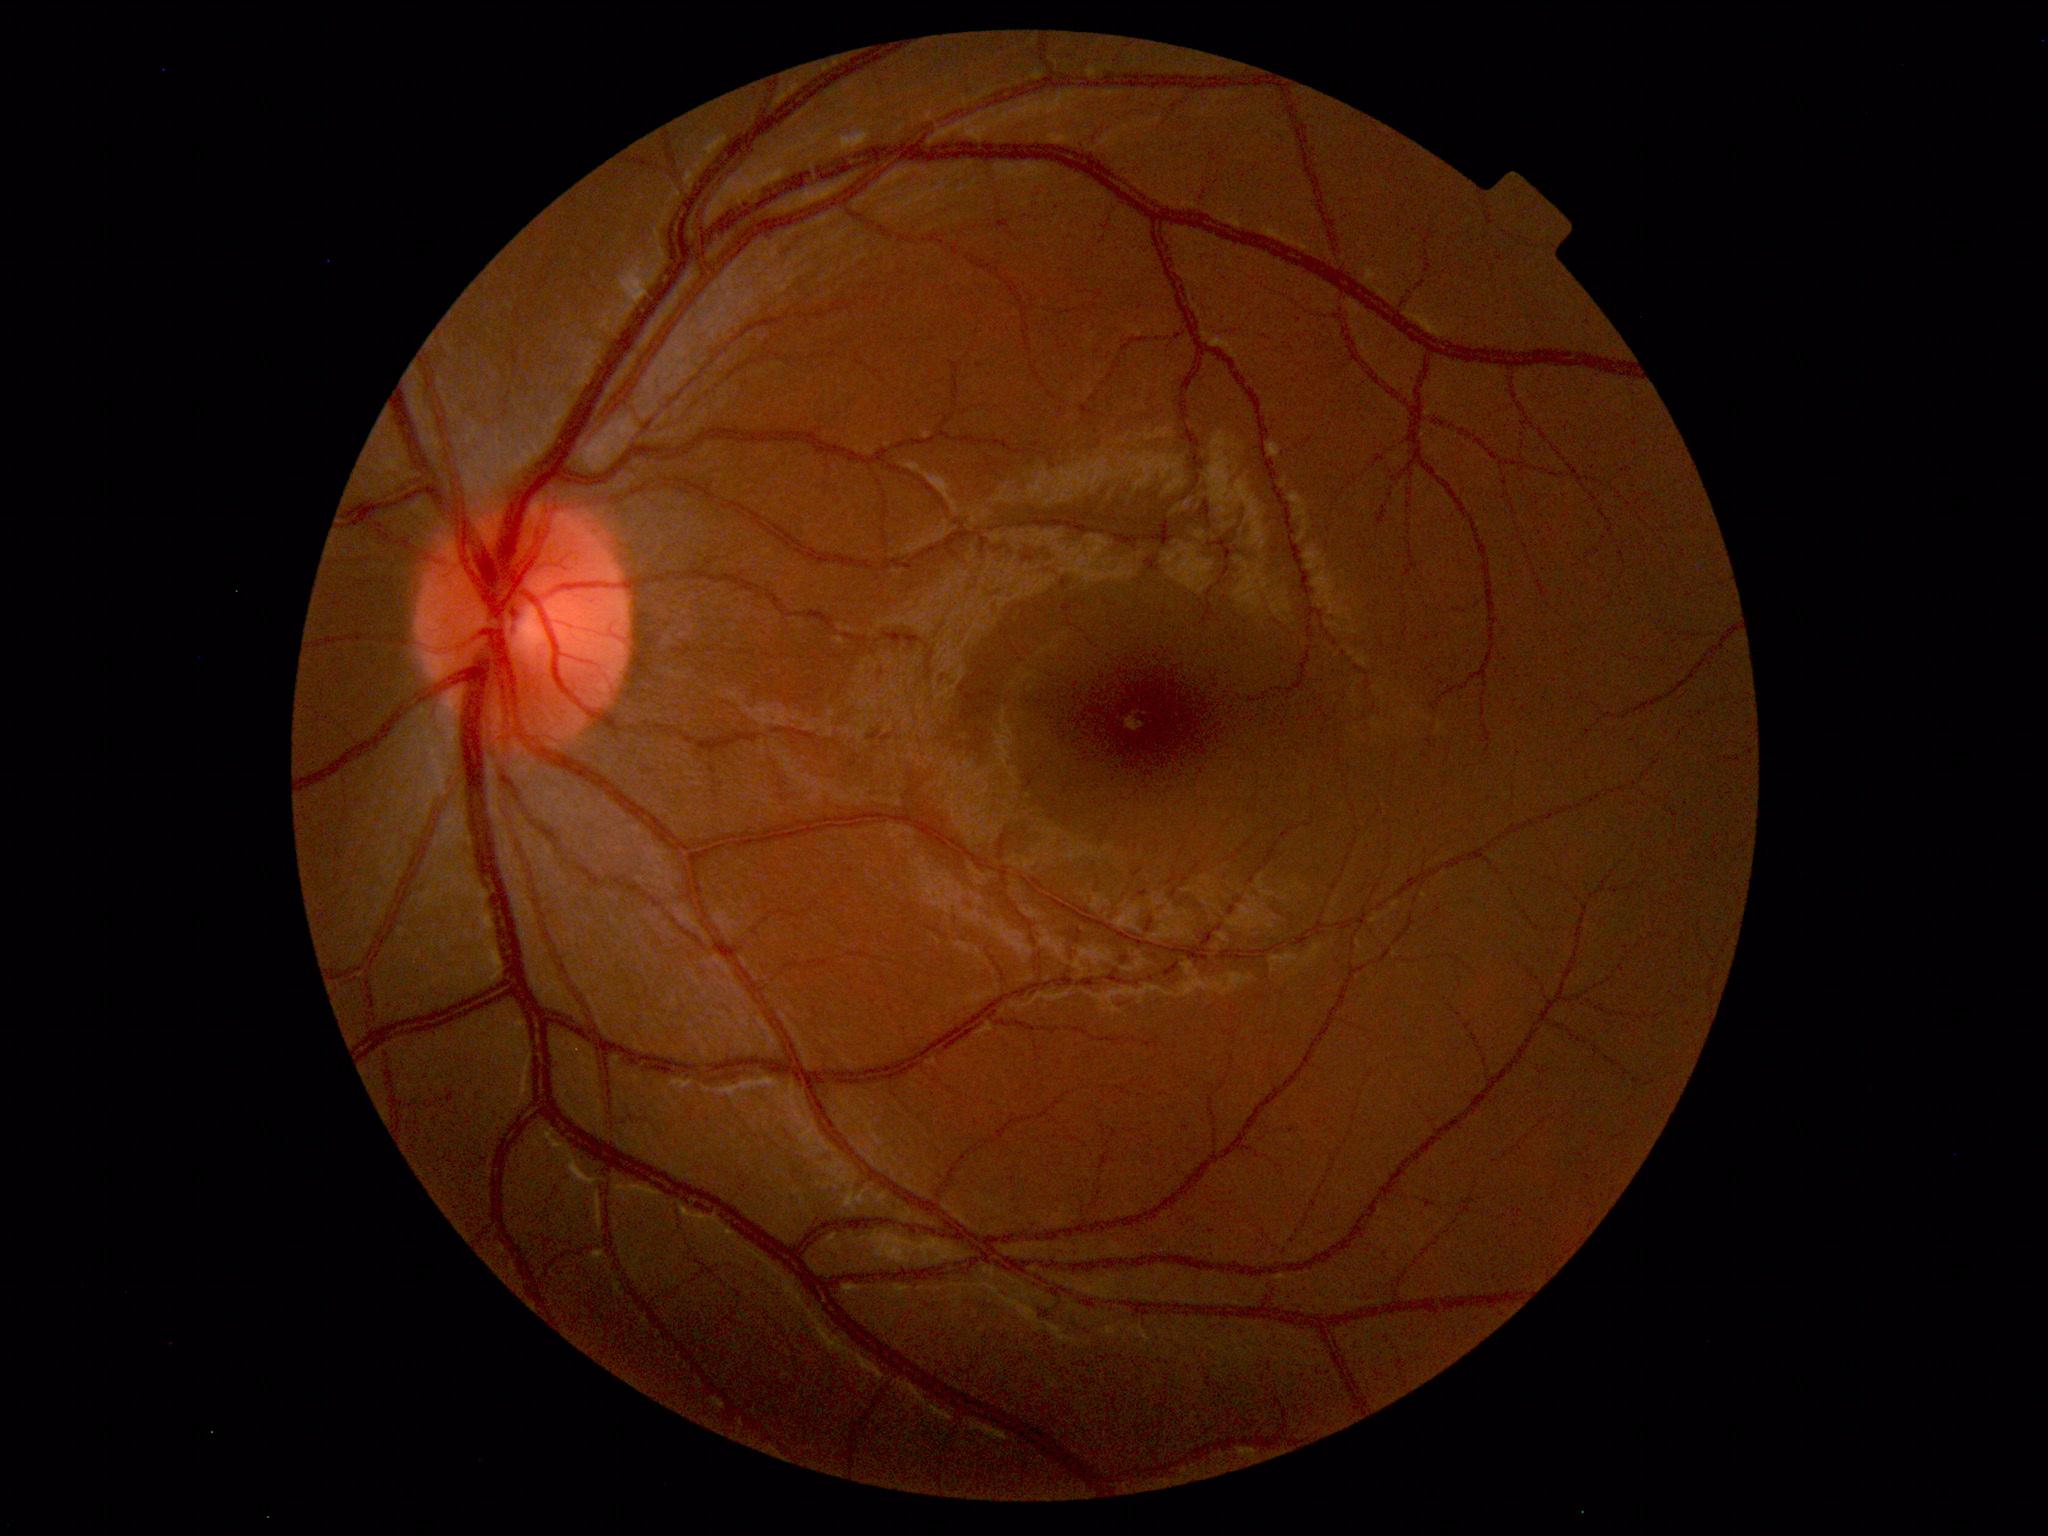
Findings: none. Normal fundus.